Image size 1932x1932; centered on the macula:
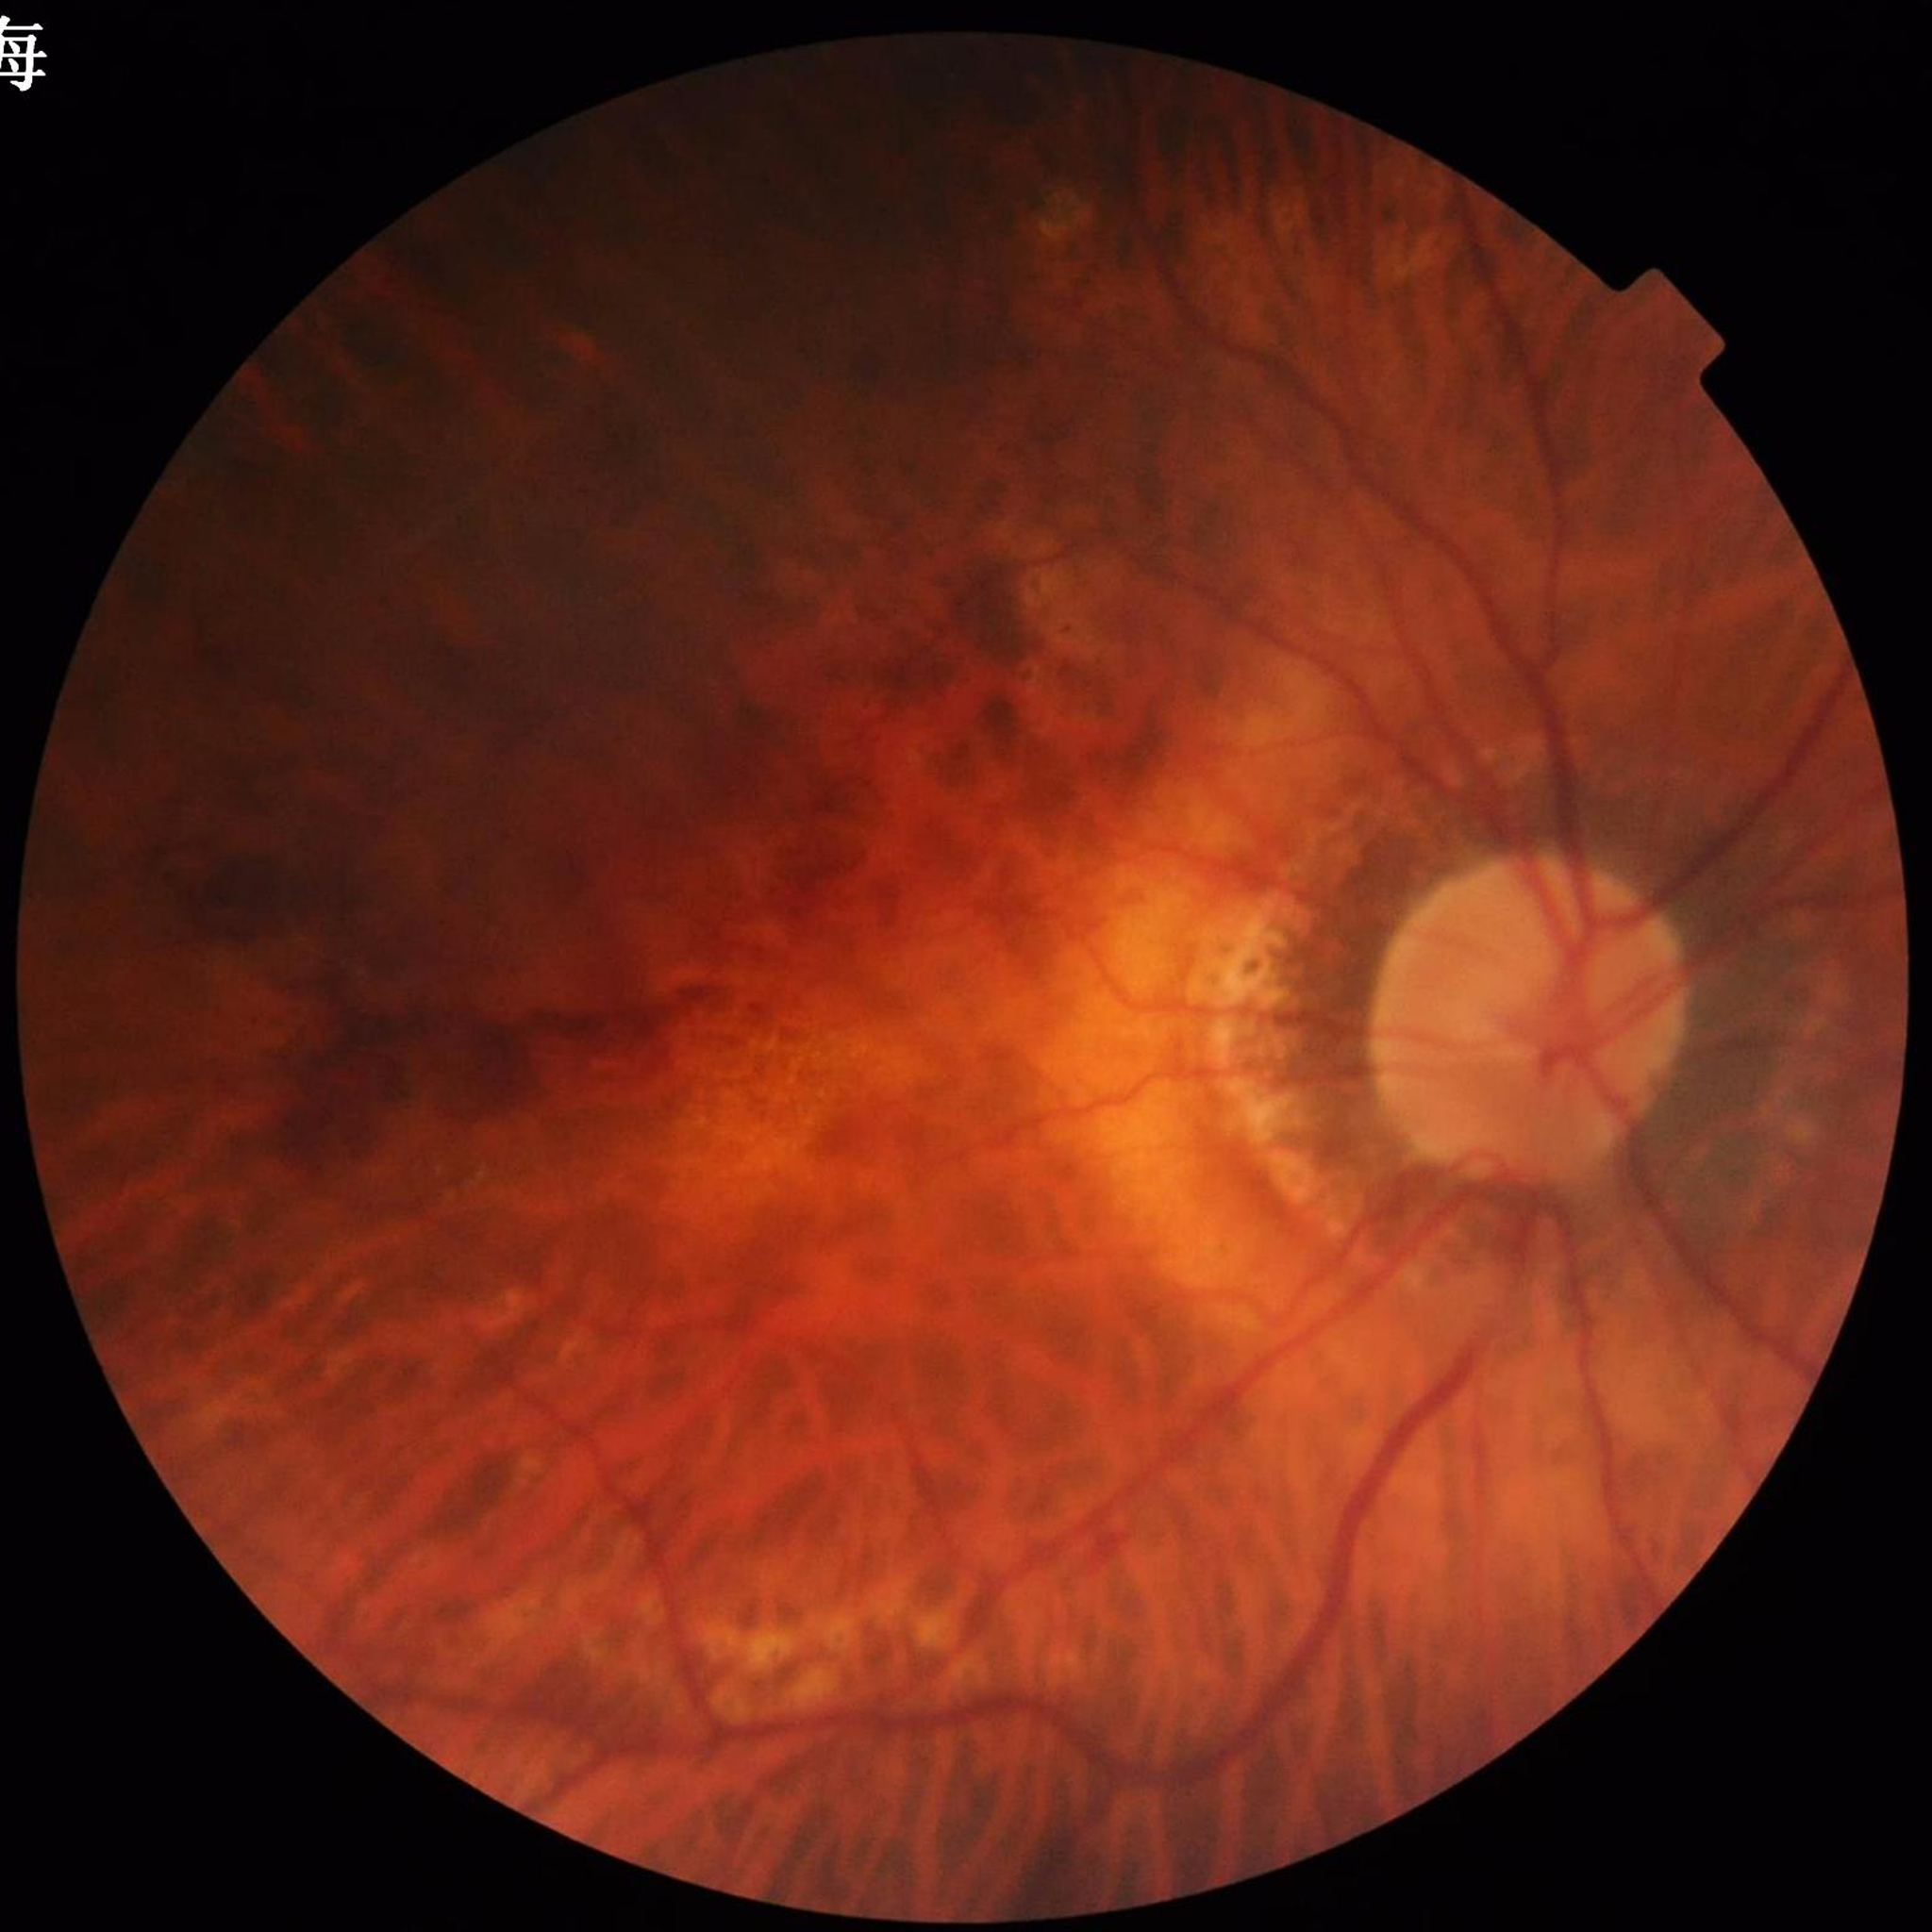

Diagnosis: age-related macular degeneration.